640x480 · RetCam wide-field infant fundus image.
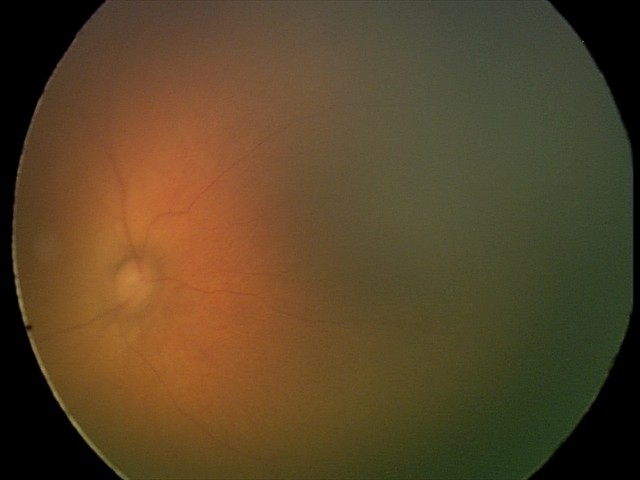 Screening examination with no abnormal retinal findings.